Color fundus image · FOV: 45 degrees · 2212 x 1659 pixels — 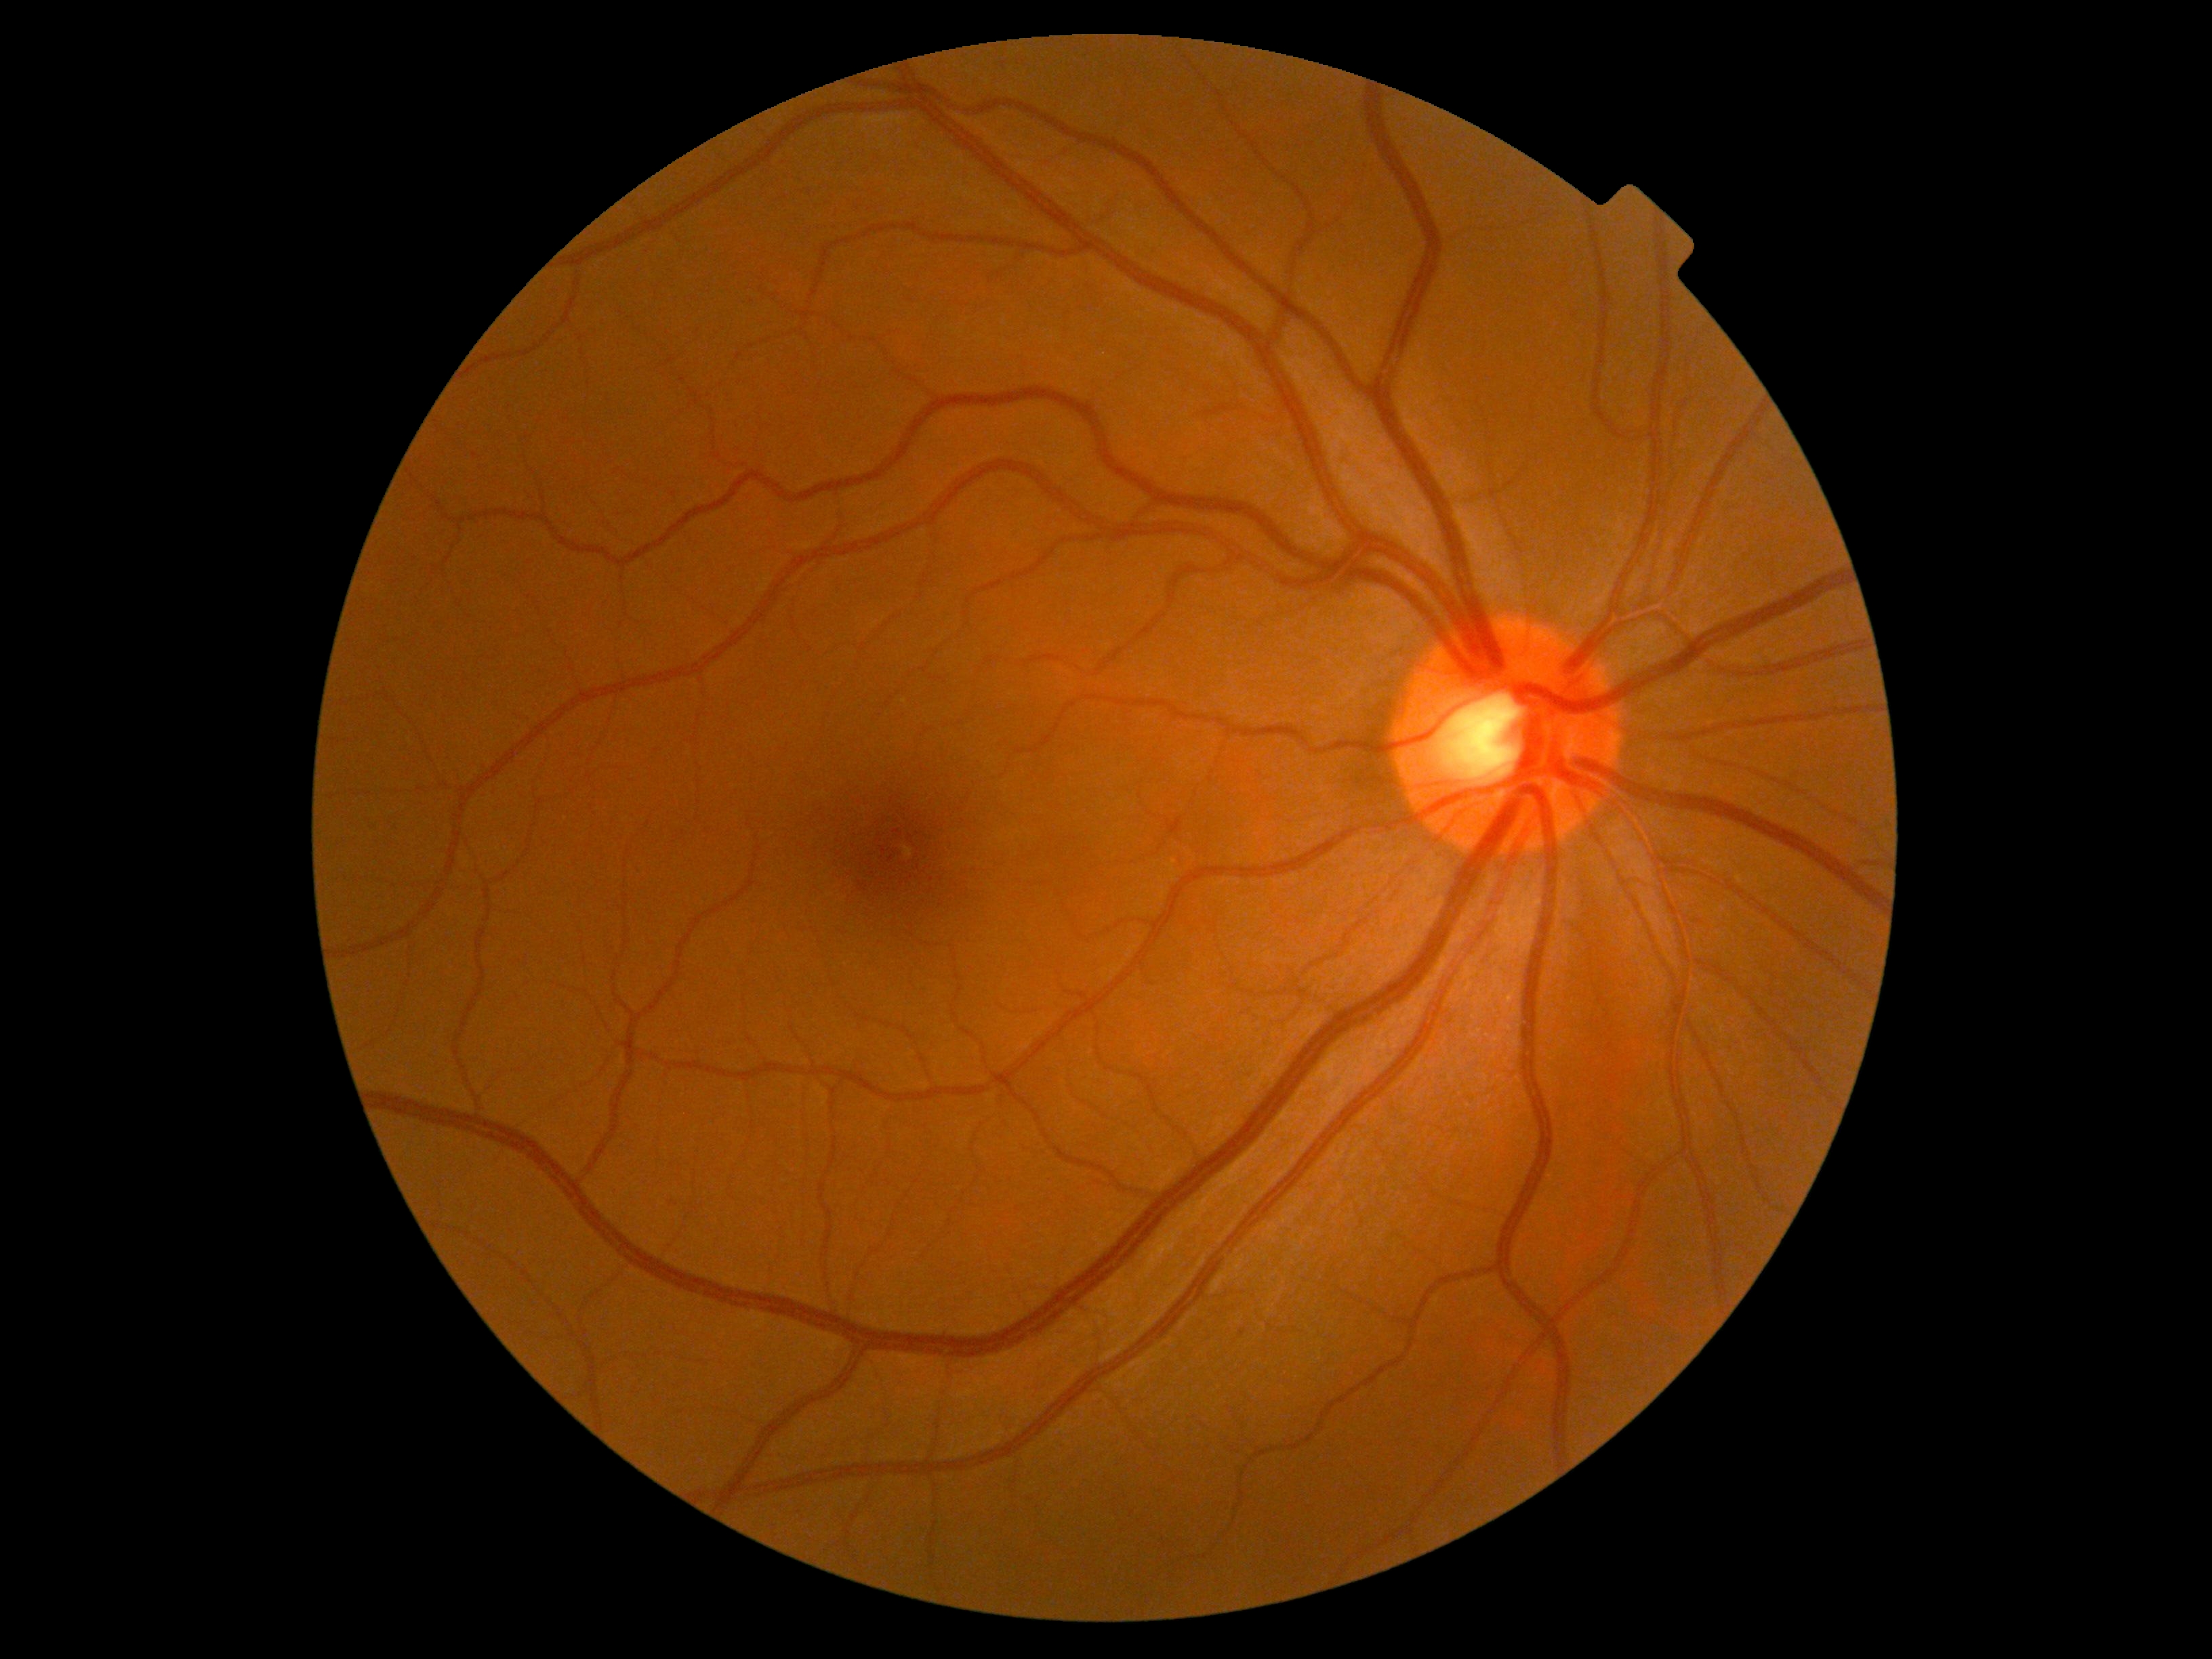 DR stage is grade 0 (no apparent retinopathy).